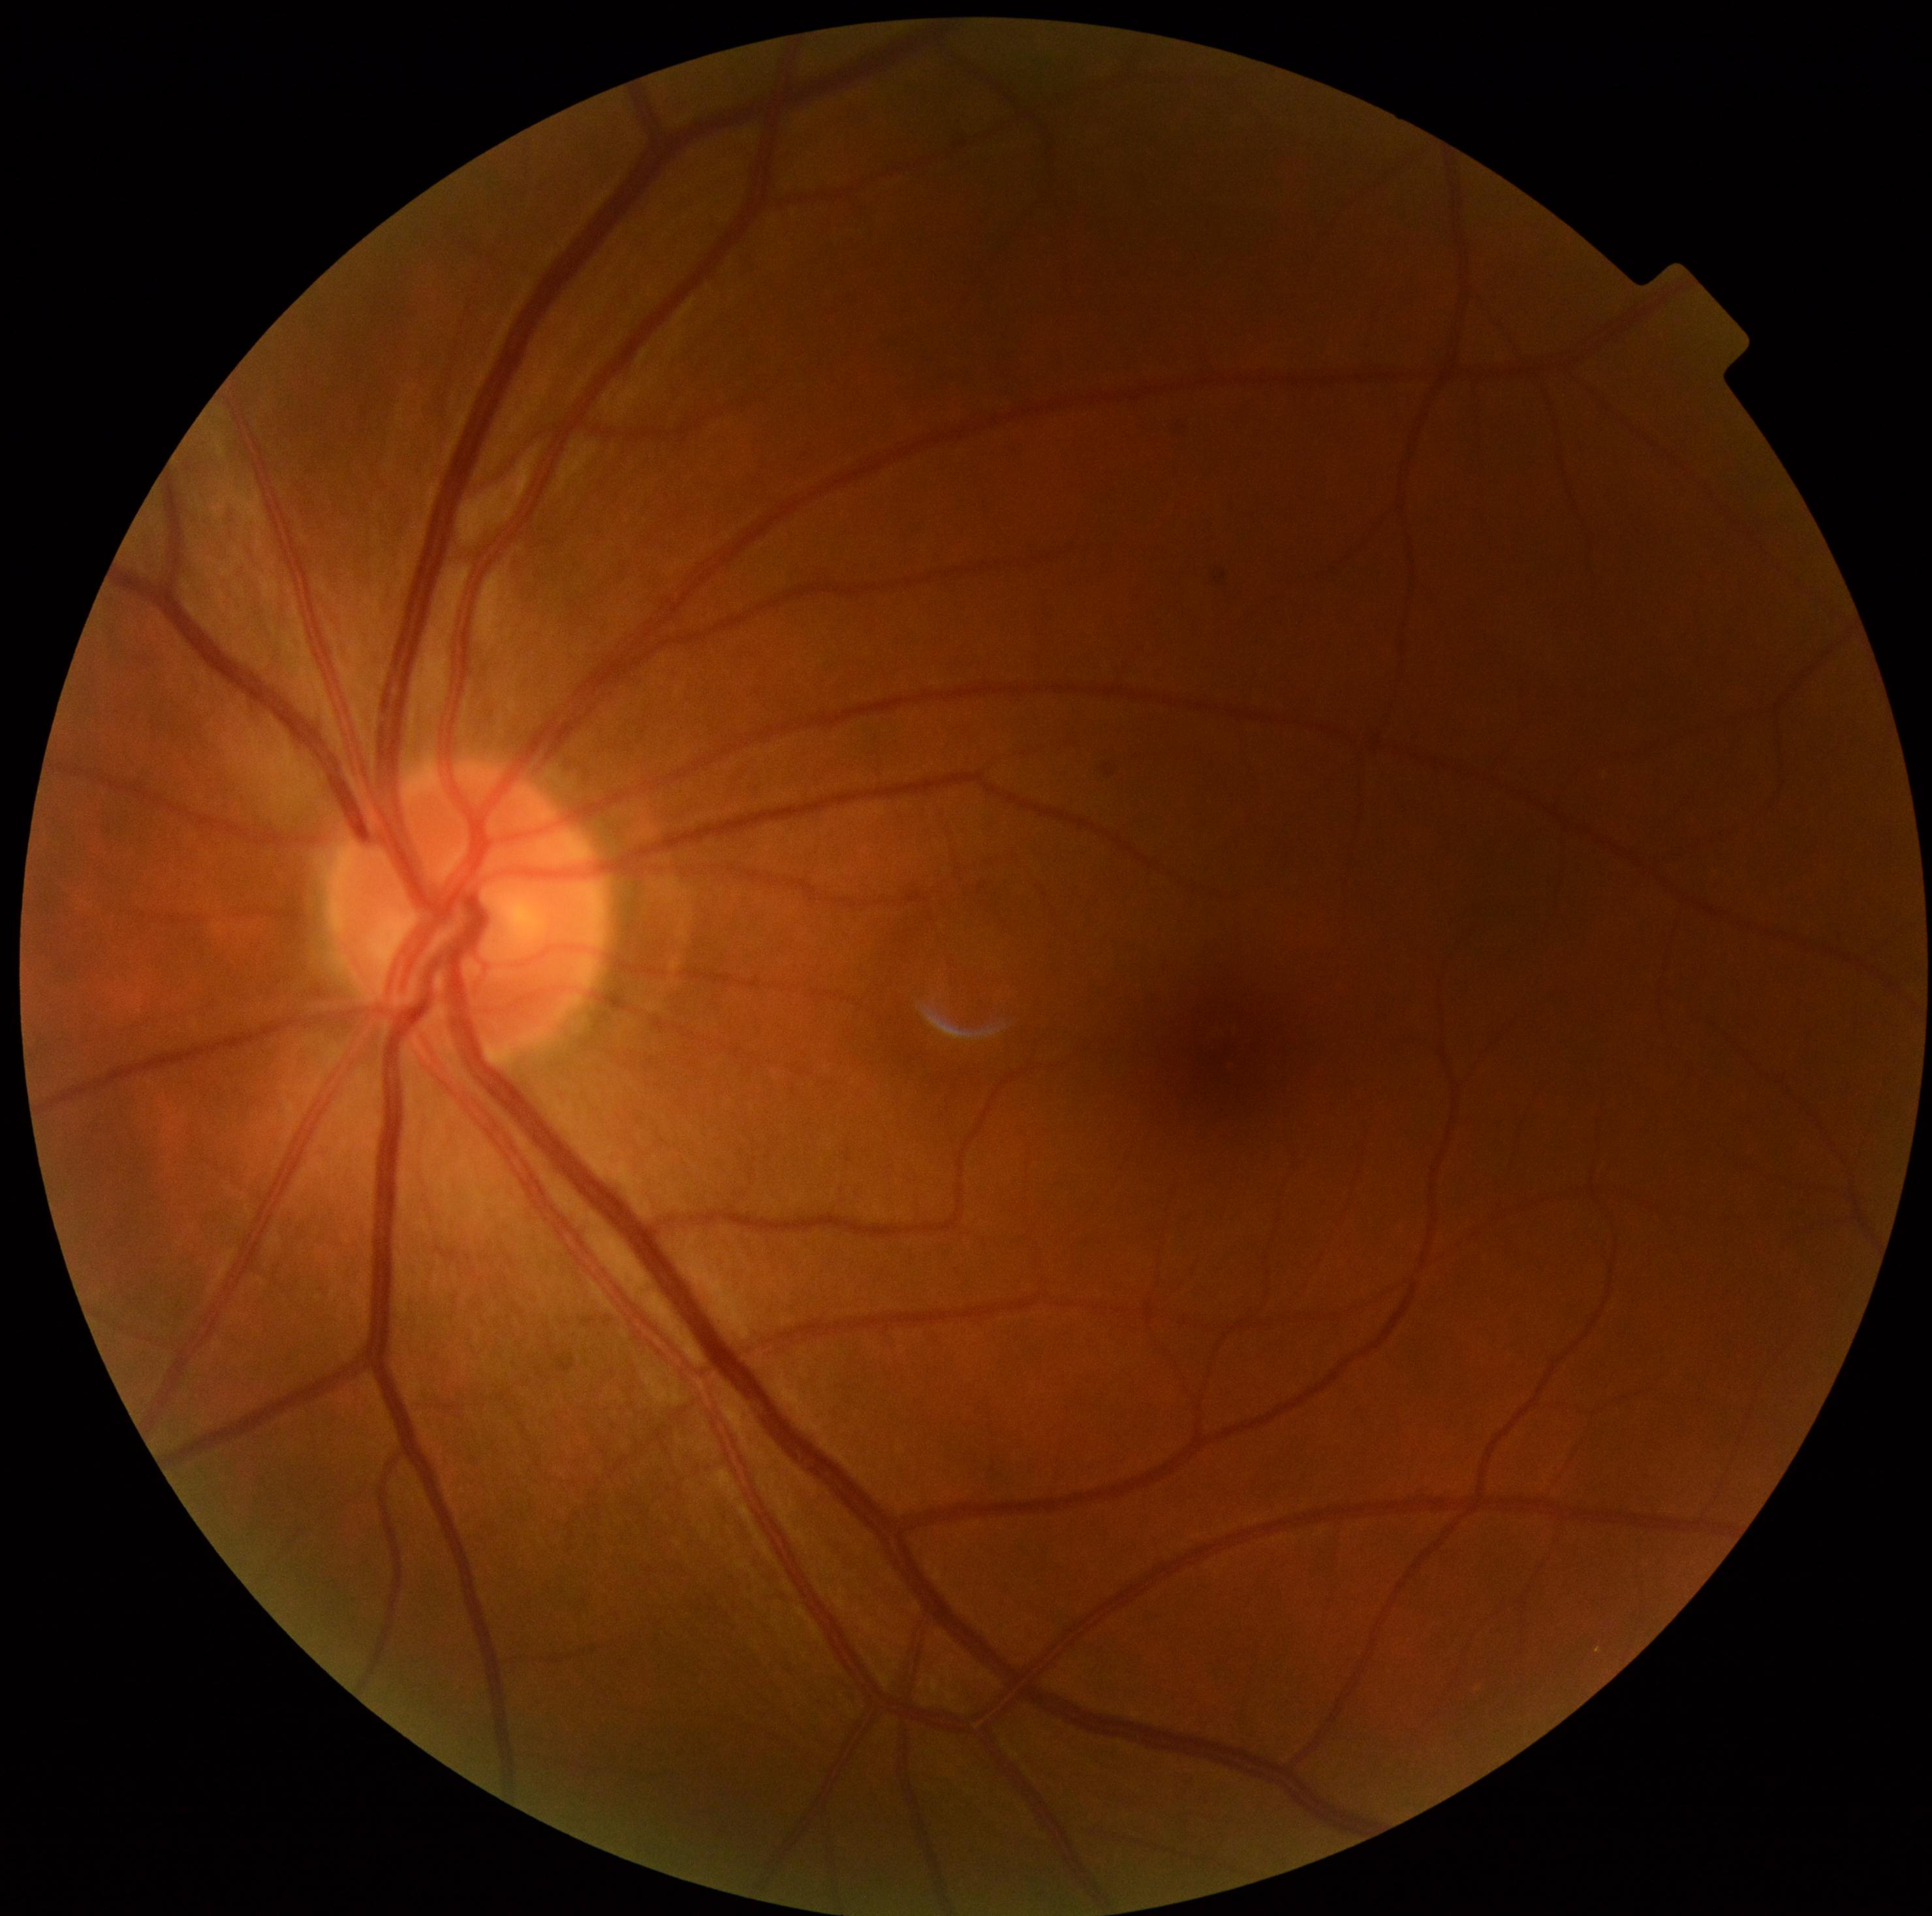
Diabetic retinopathy (DR): no apparent diabetic retinopathy (grade 0).